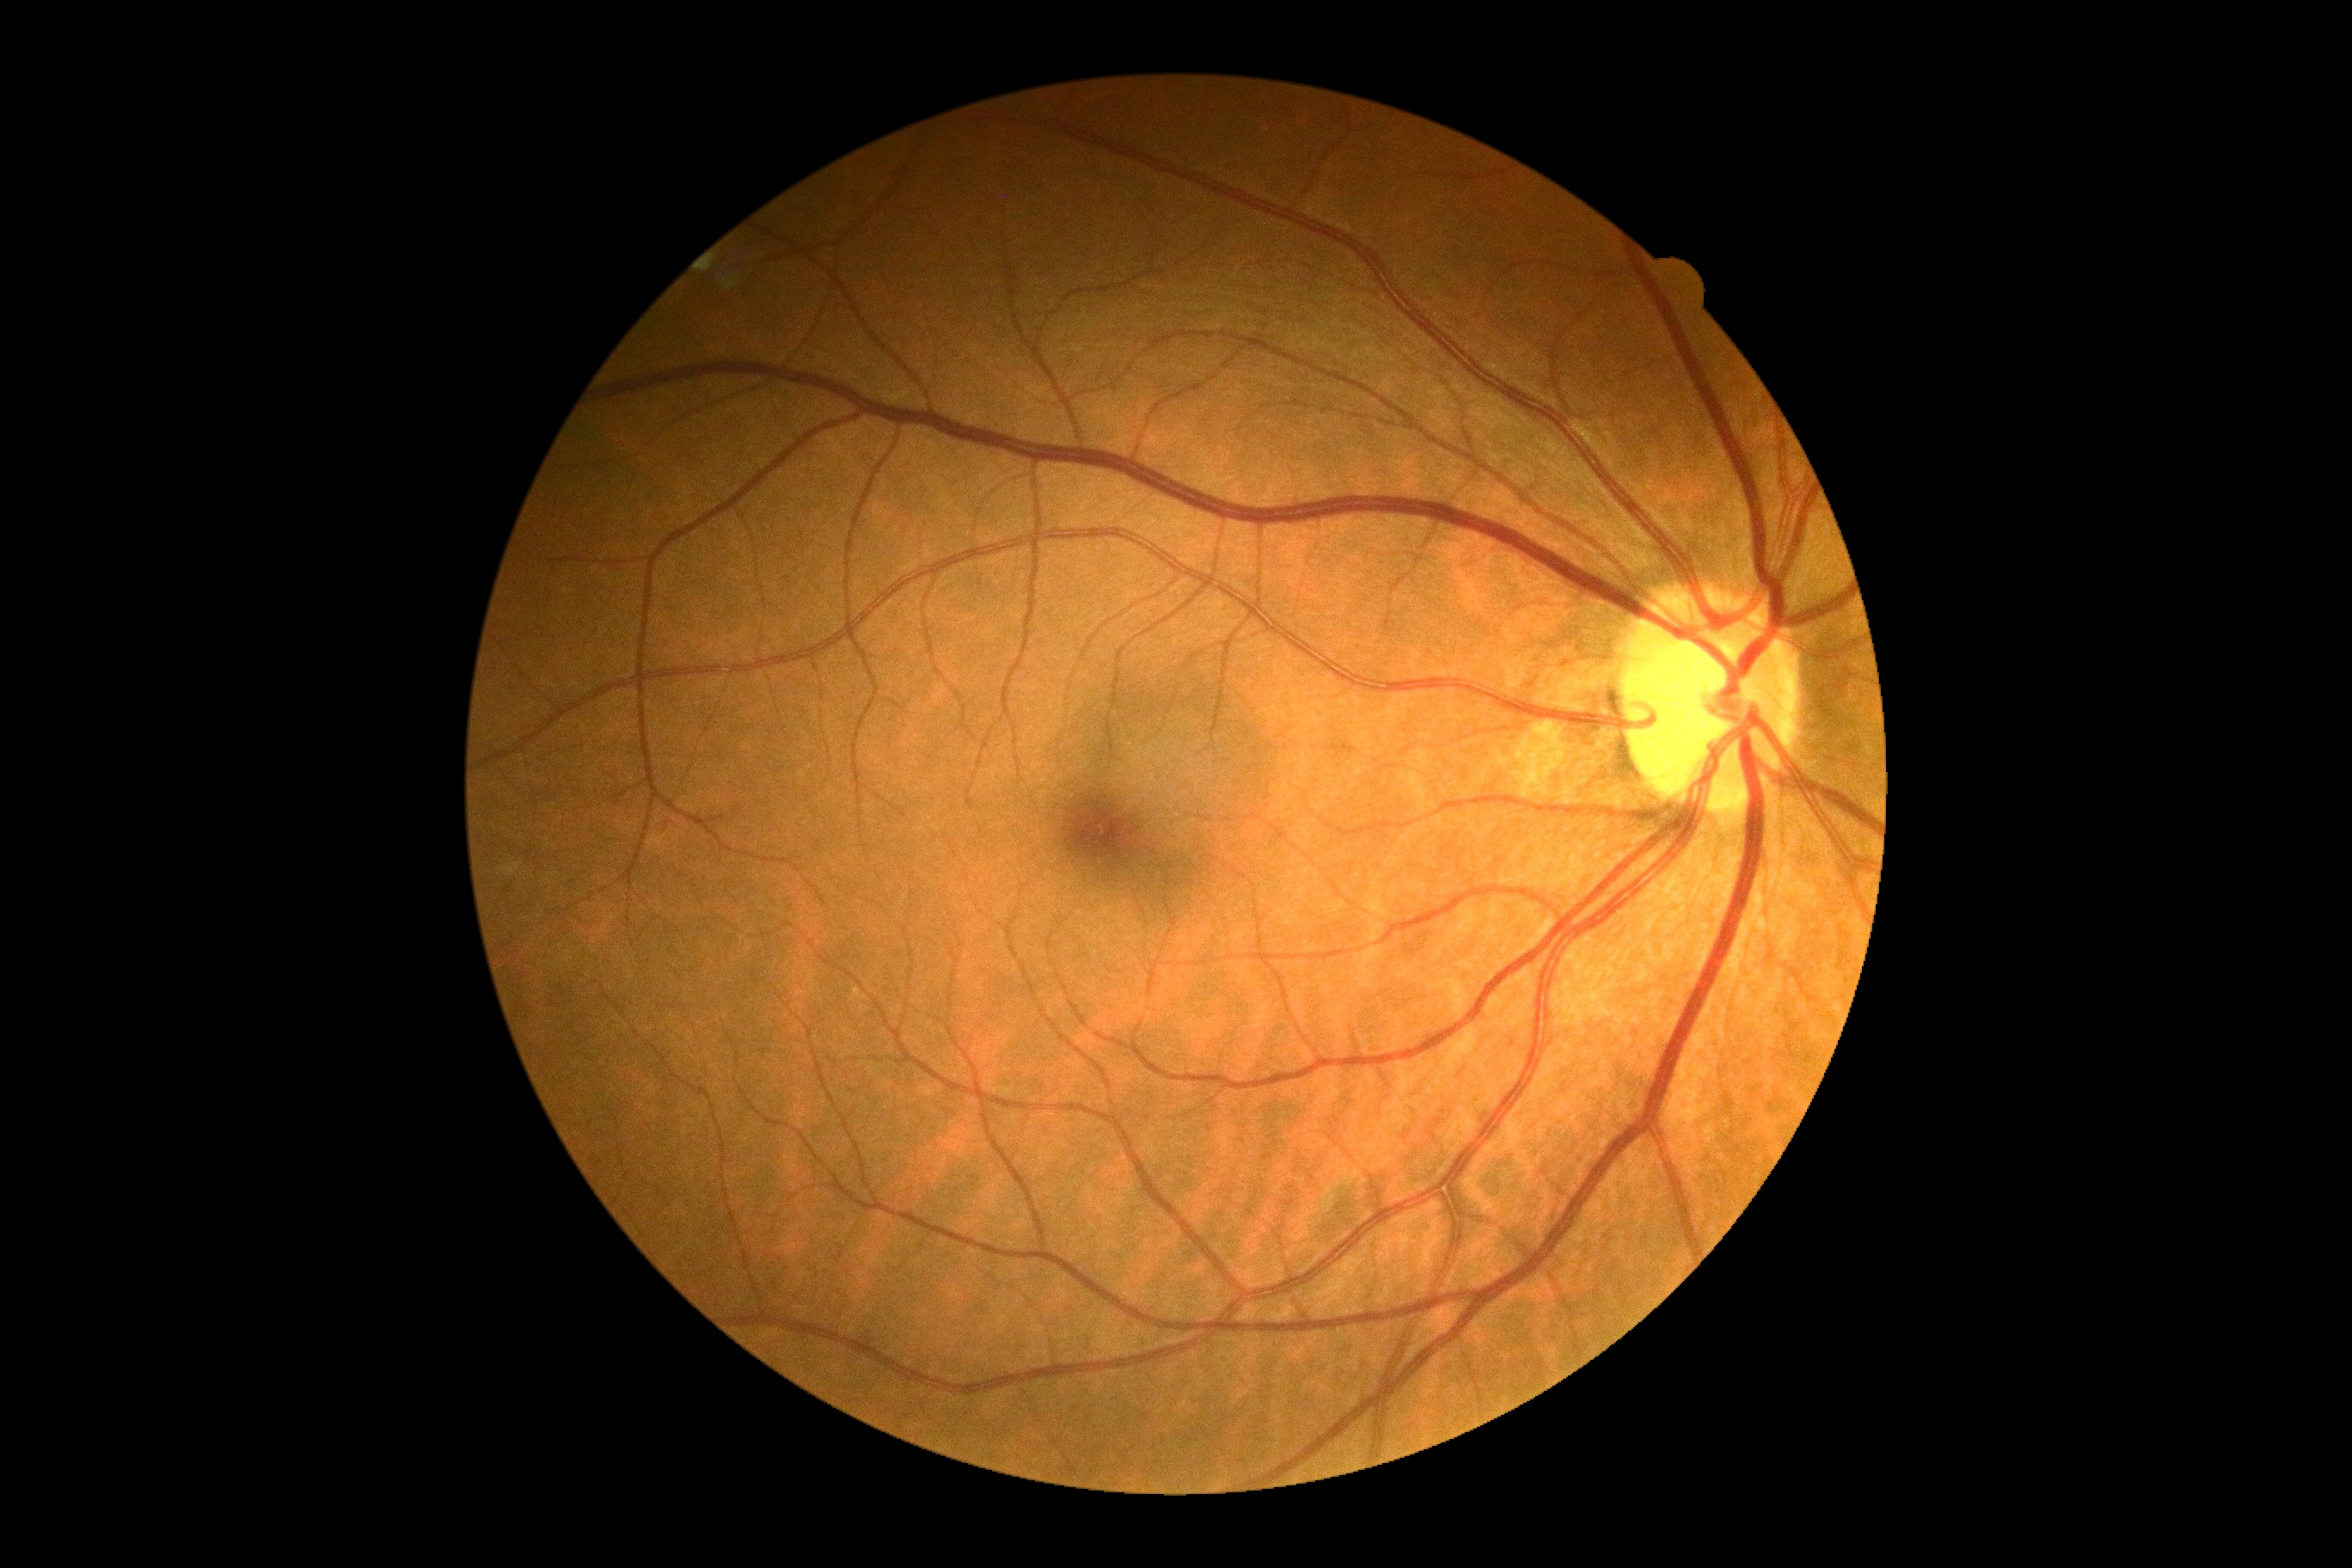
retinopathy grade = 0/4.